1659x2212px:
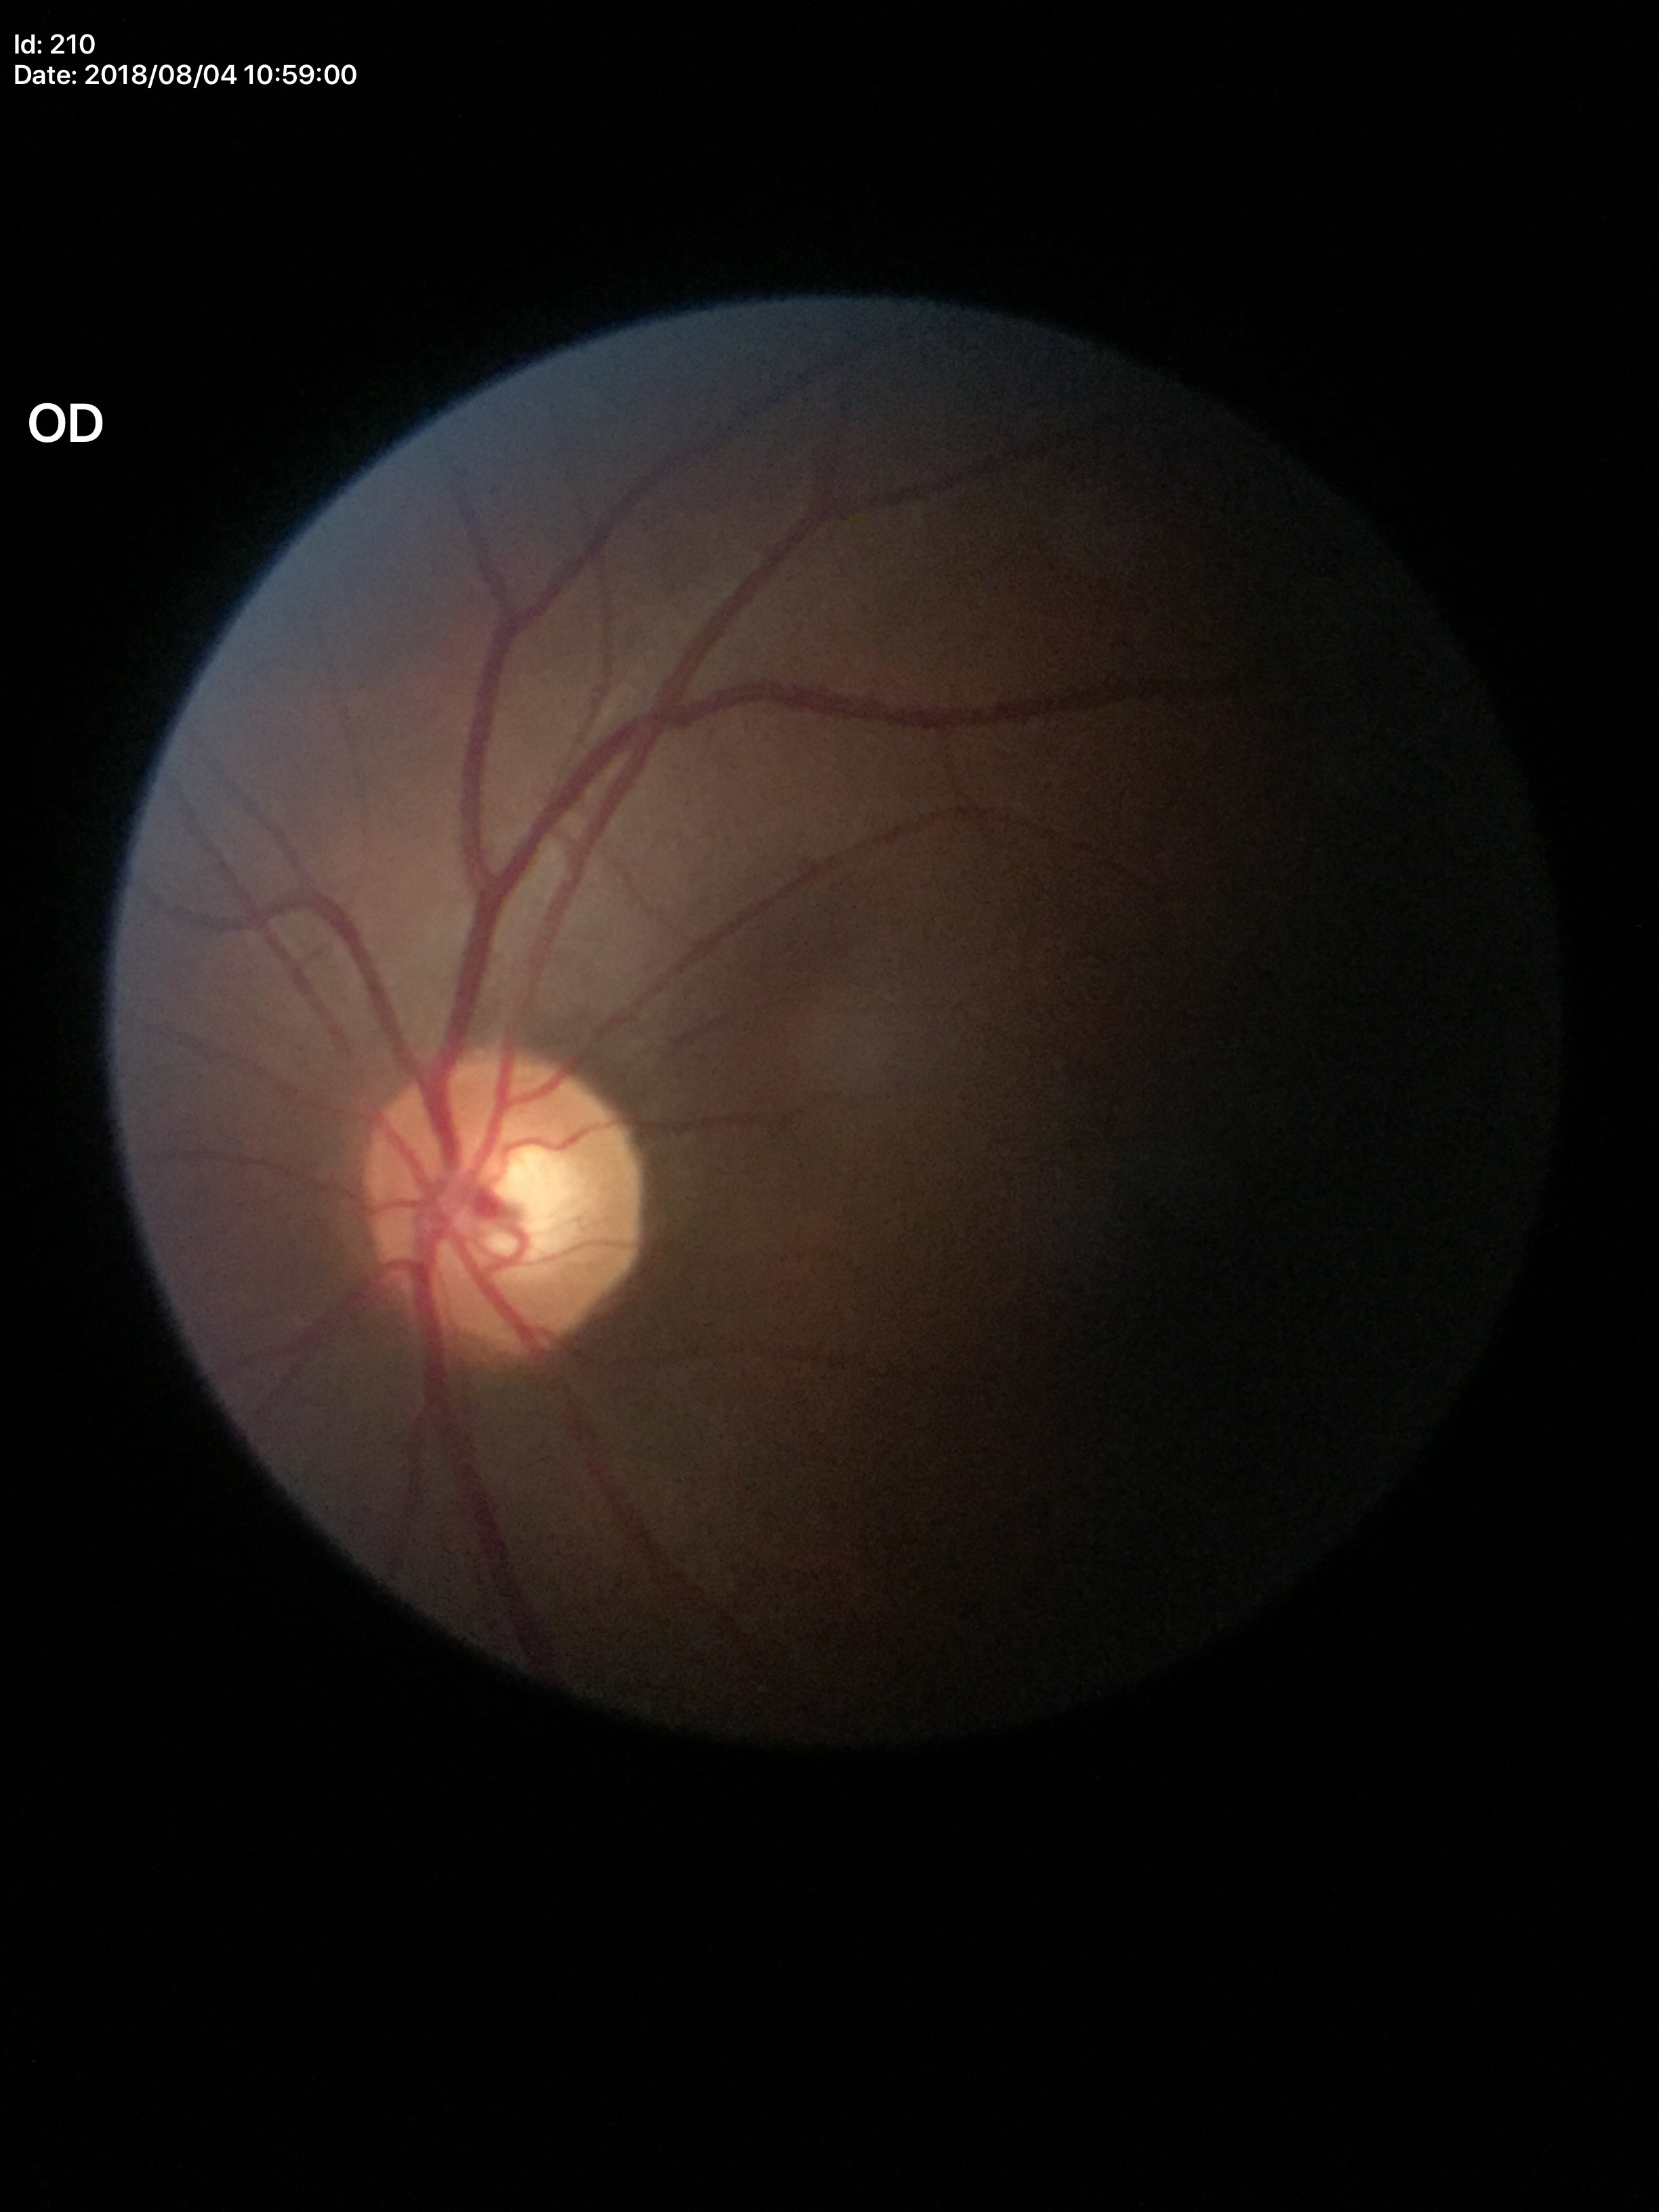
Vertical cup-disc ratio (VCDR) of 0.55. Horizontal cup-disc ratio (HCDR): 0.59. Not suspicious for glaucoma.